No pharmacologic dilation.
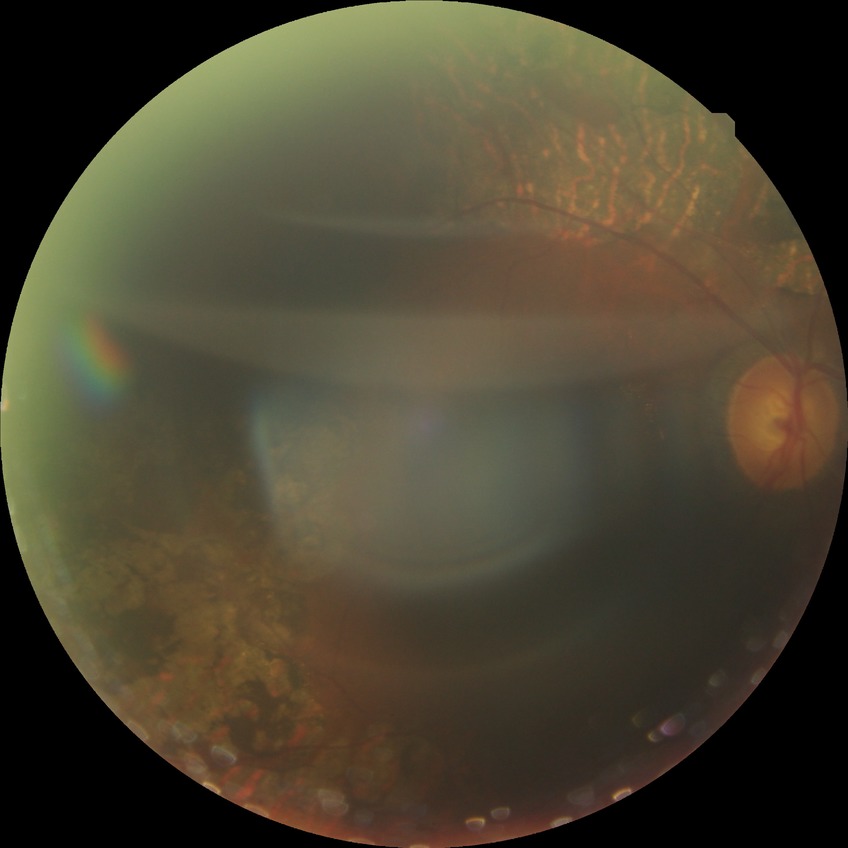

Diabetic retinopathy stage: proliferative diabetic retinopathy.